Wide-field retinal mosaic image; 200° FOV; 1924 x 1556 pixels
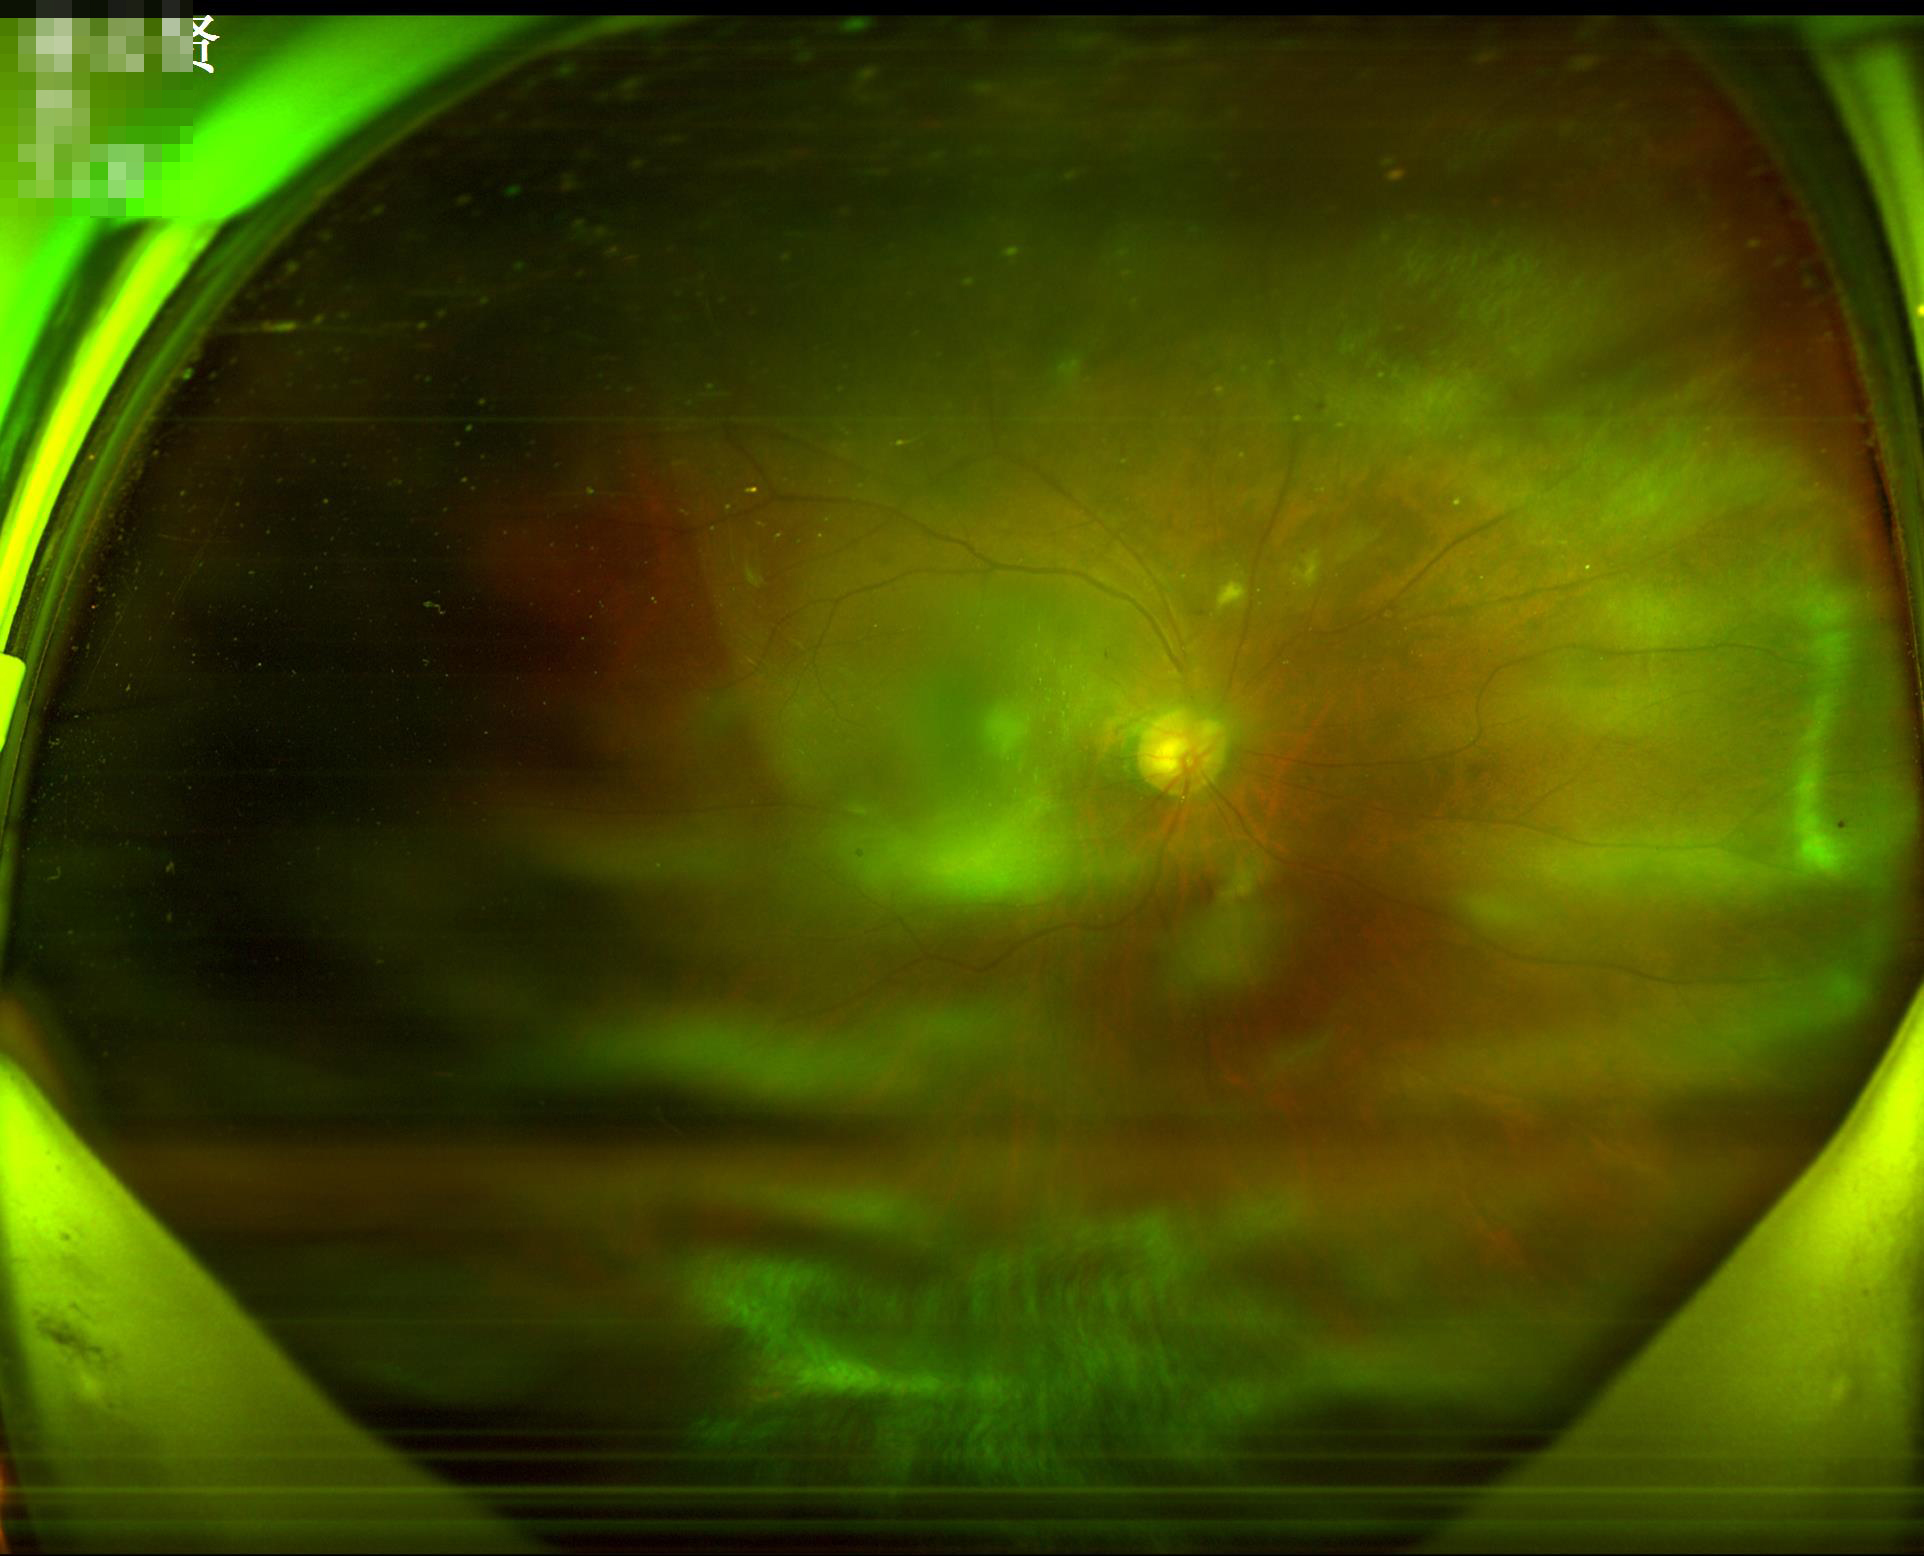
Out of focus; structures are indistinct. Illumination is uneven. Image quality is inadequate for diagnostic use.